Modified Davis grading · image size 848x848: 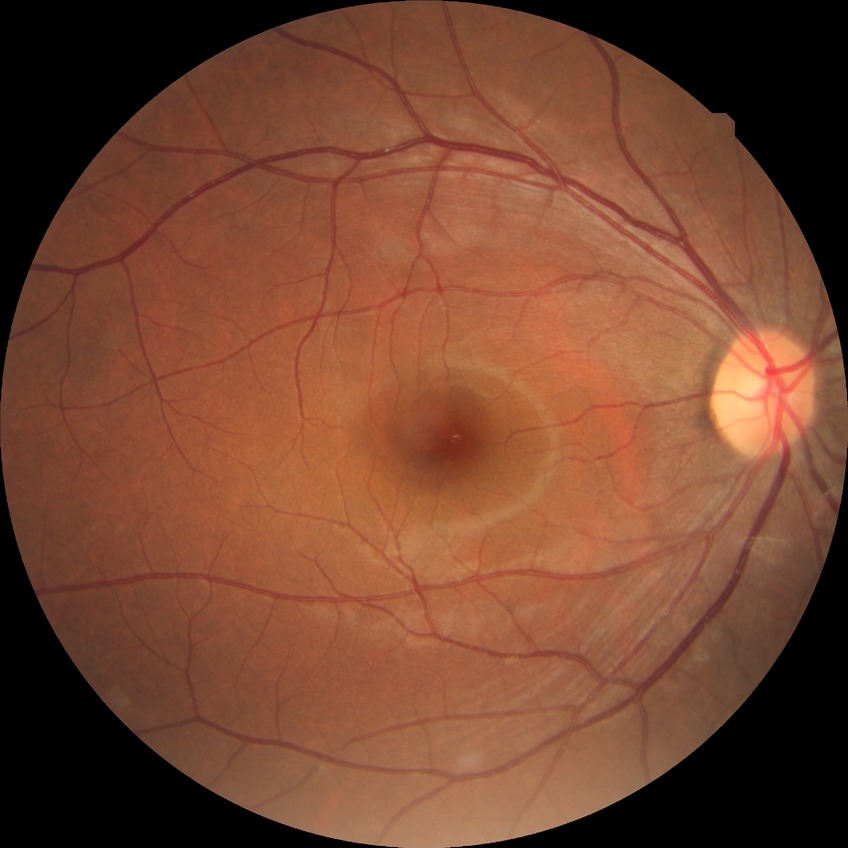

modified Davis grade: NDR.